Infant wide-field retinal image; captured with the Clarity RetCam 3 (130° field of view) — 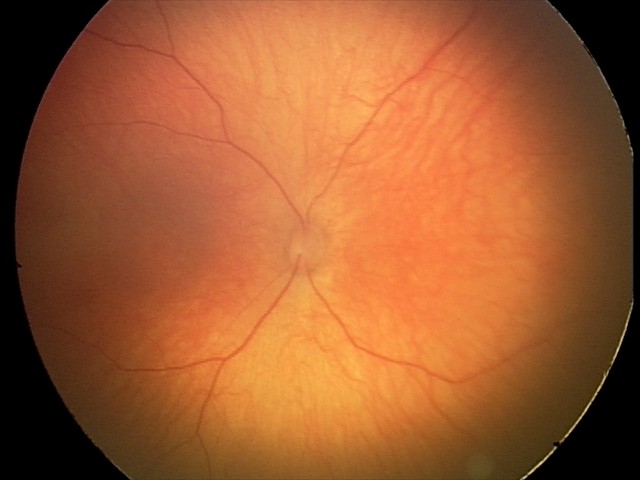
Series diagnosed as optic nerve hypoplasia.